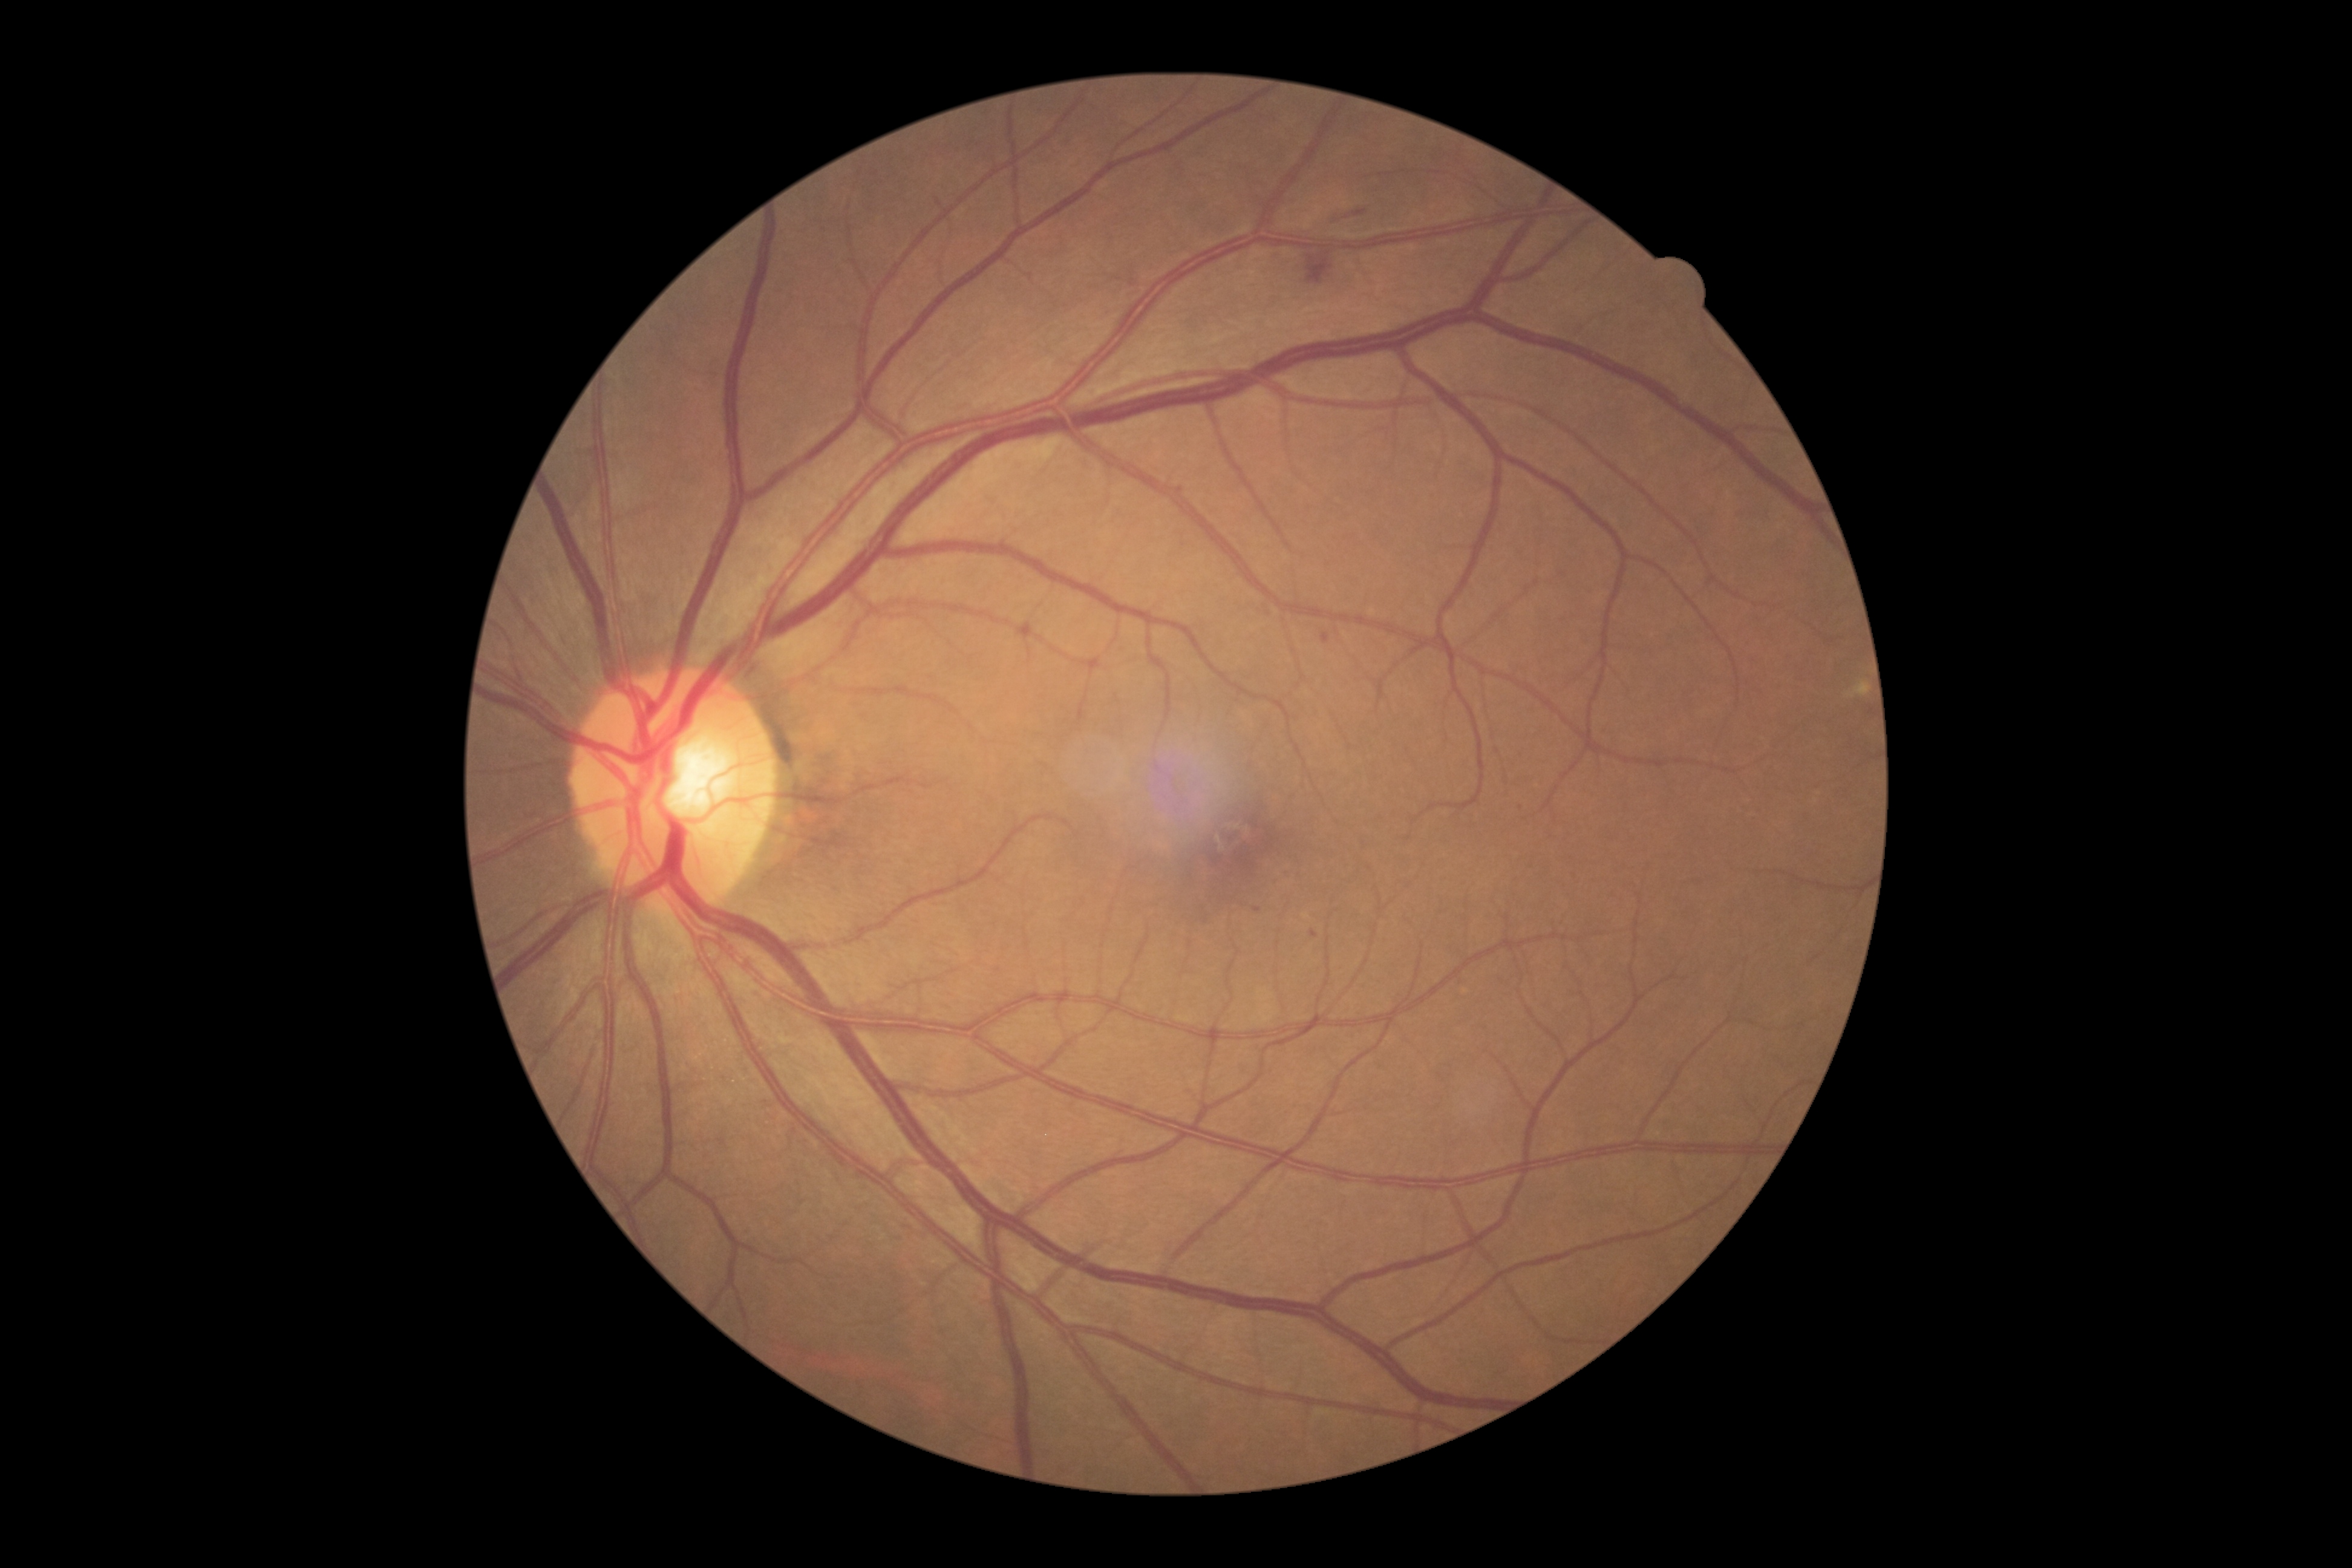 Diabetic retinopathy (DR) is 2.